45° FOV: 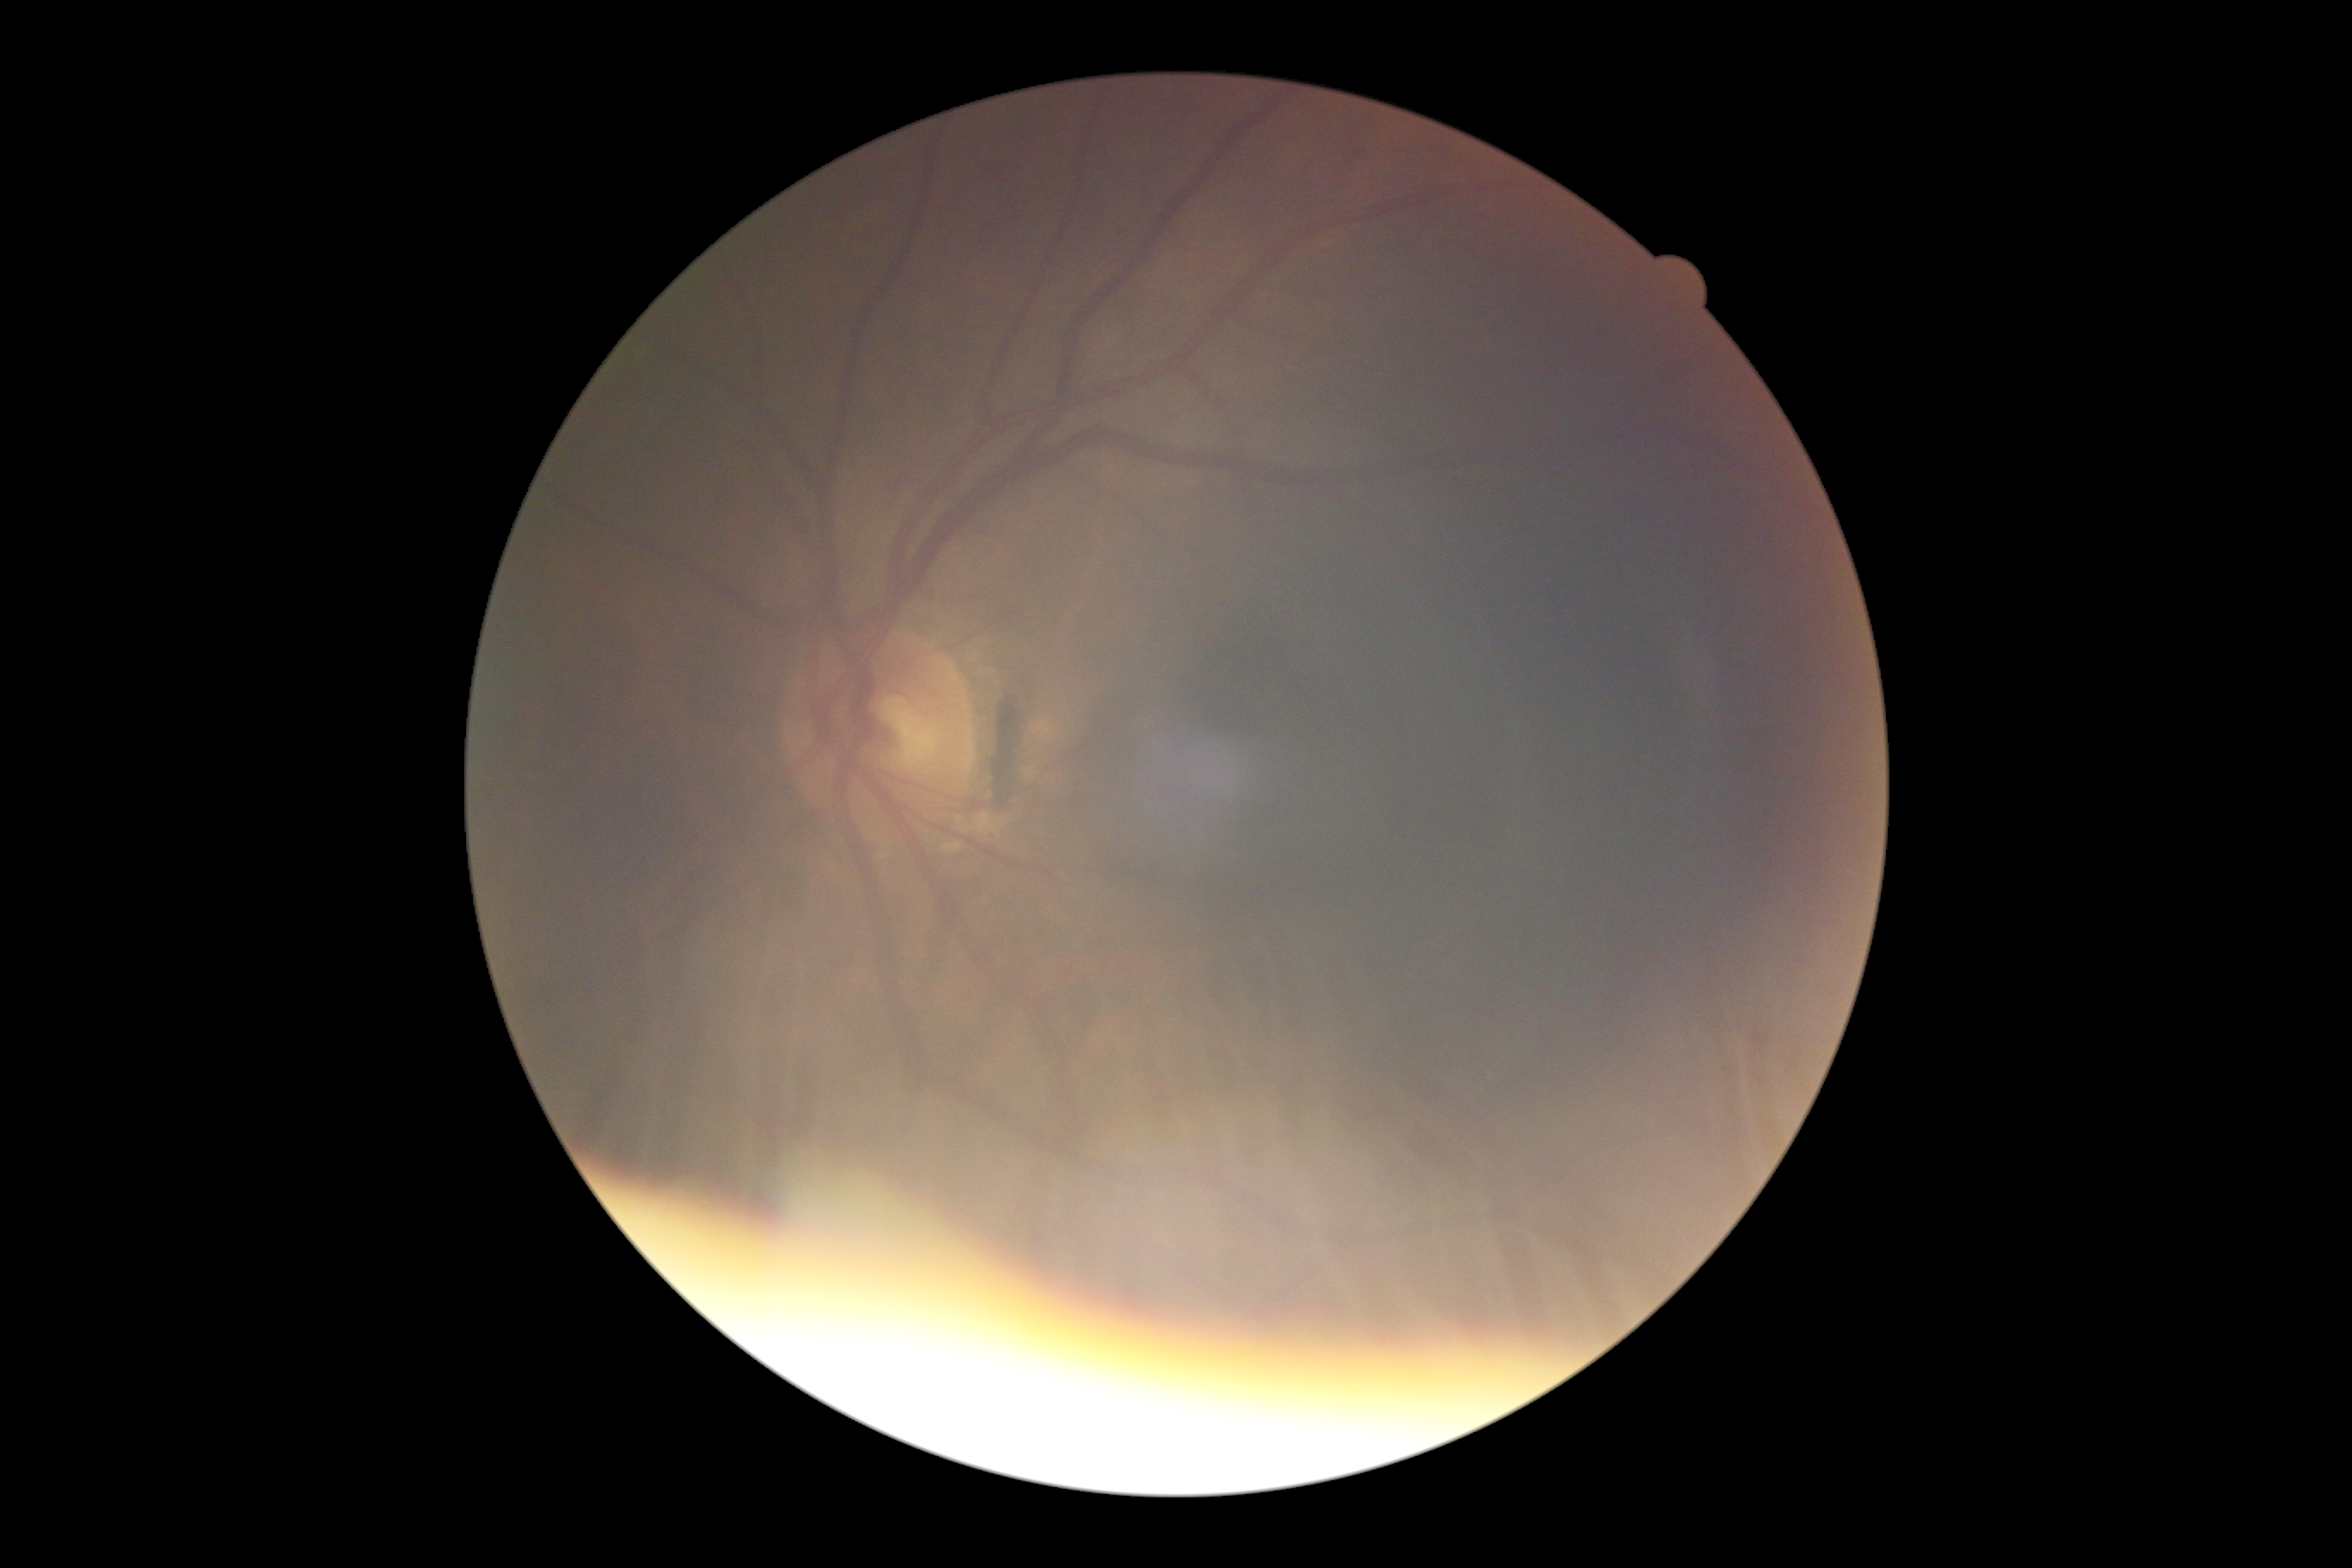

diabetic retinopathy (DR): ungradable.